1380 x 1382 pixels — 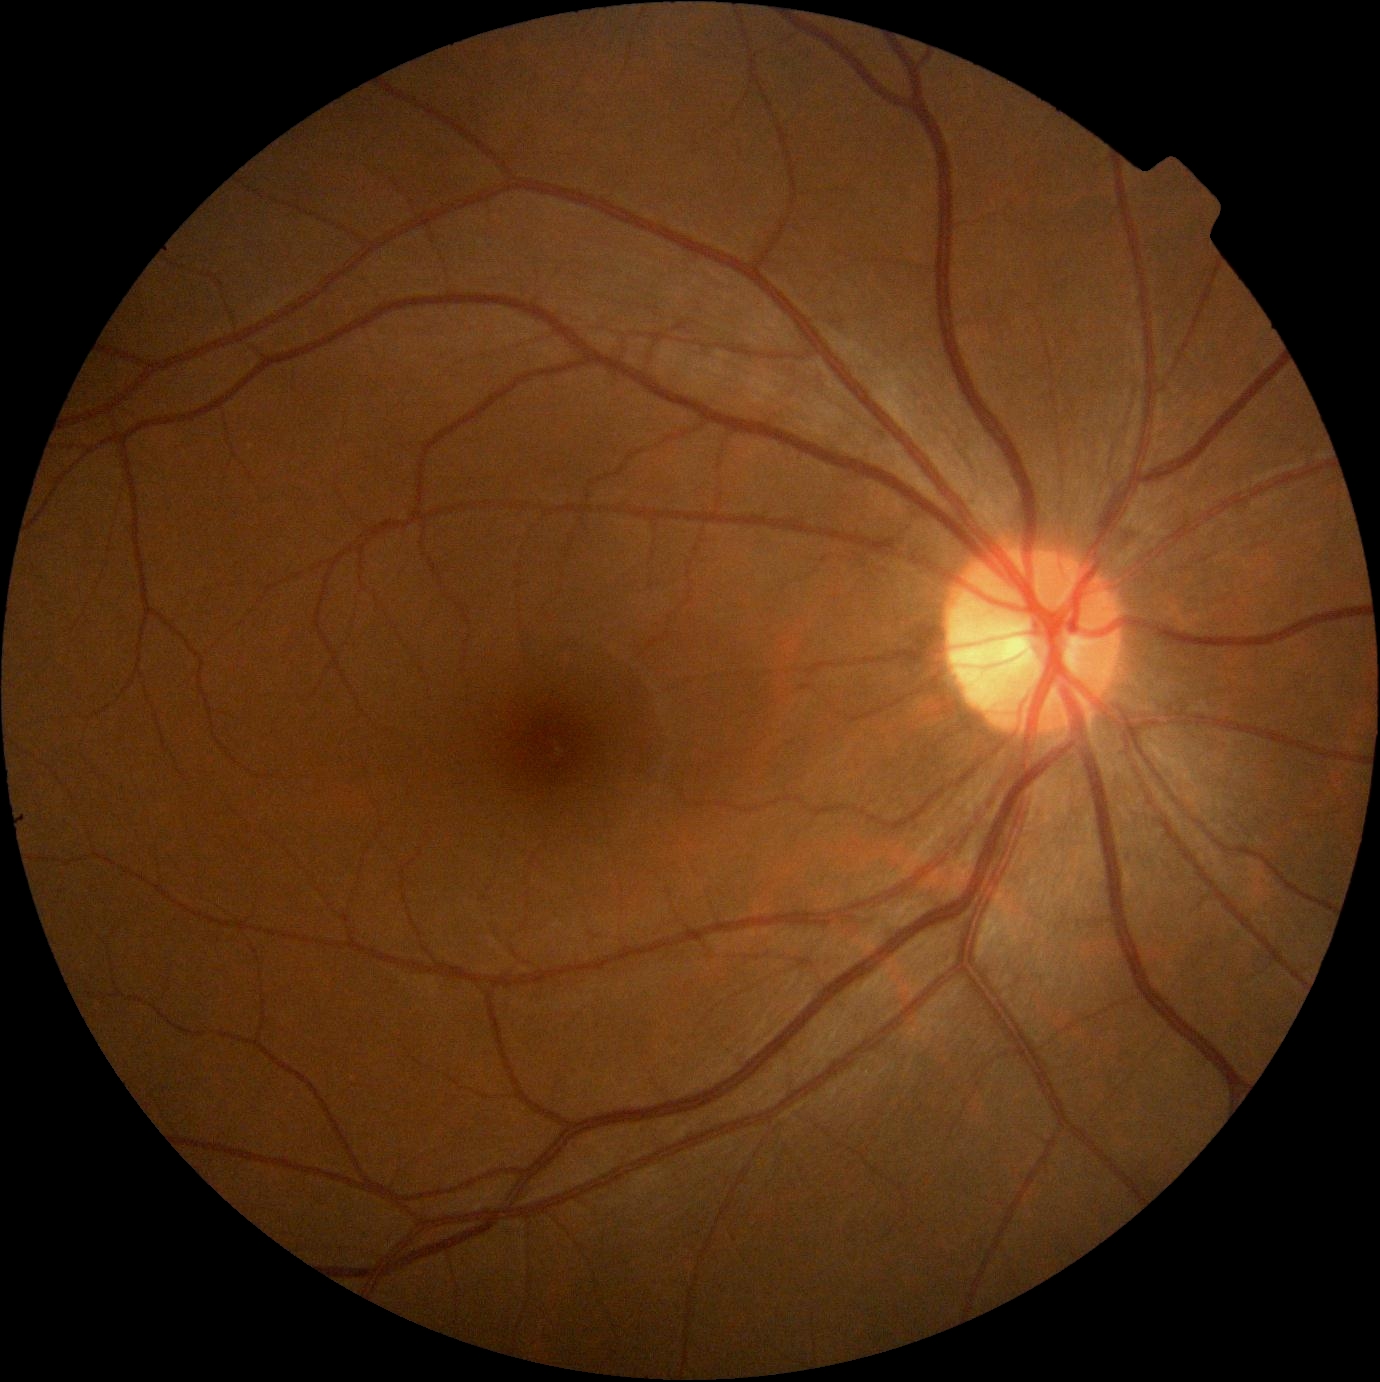

Diabetic retinopathy grade: 0.